45-degree field of view. 1920x1088px. Color fundus image.
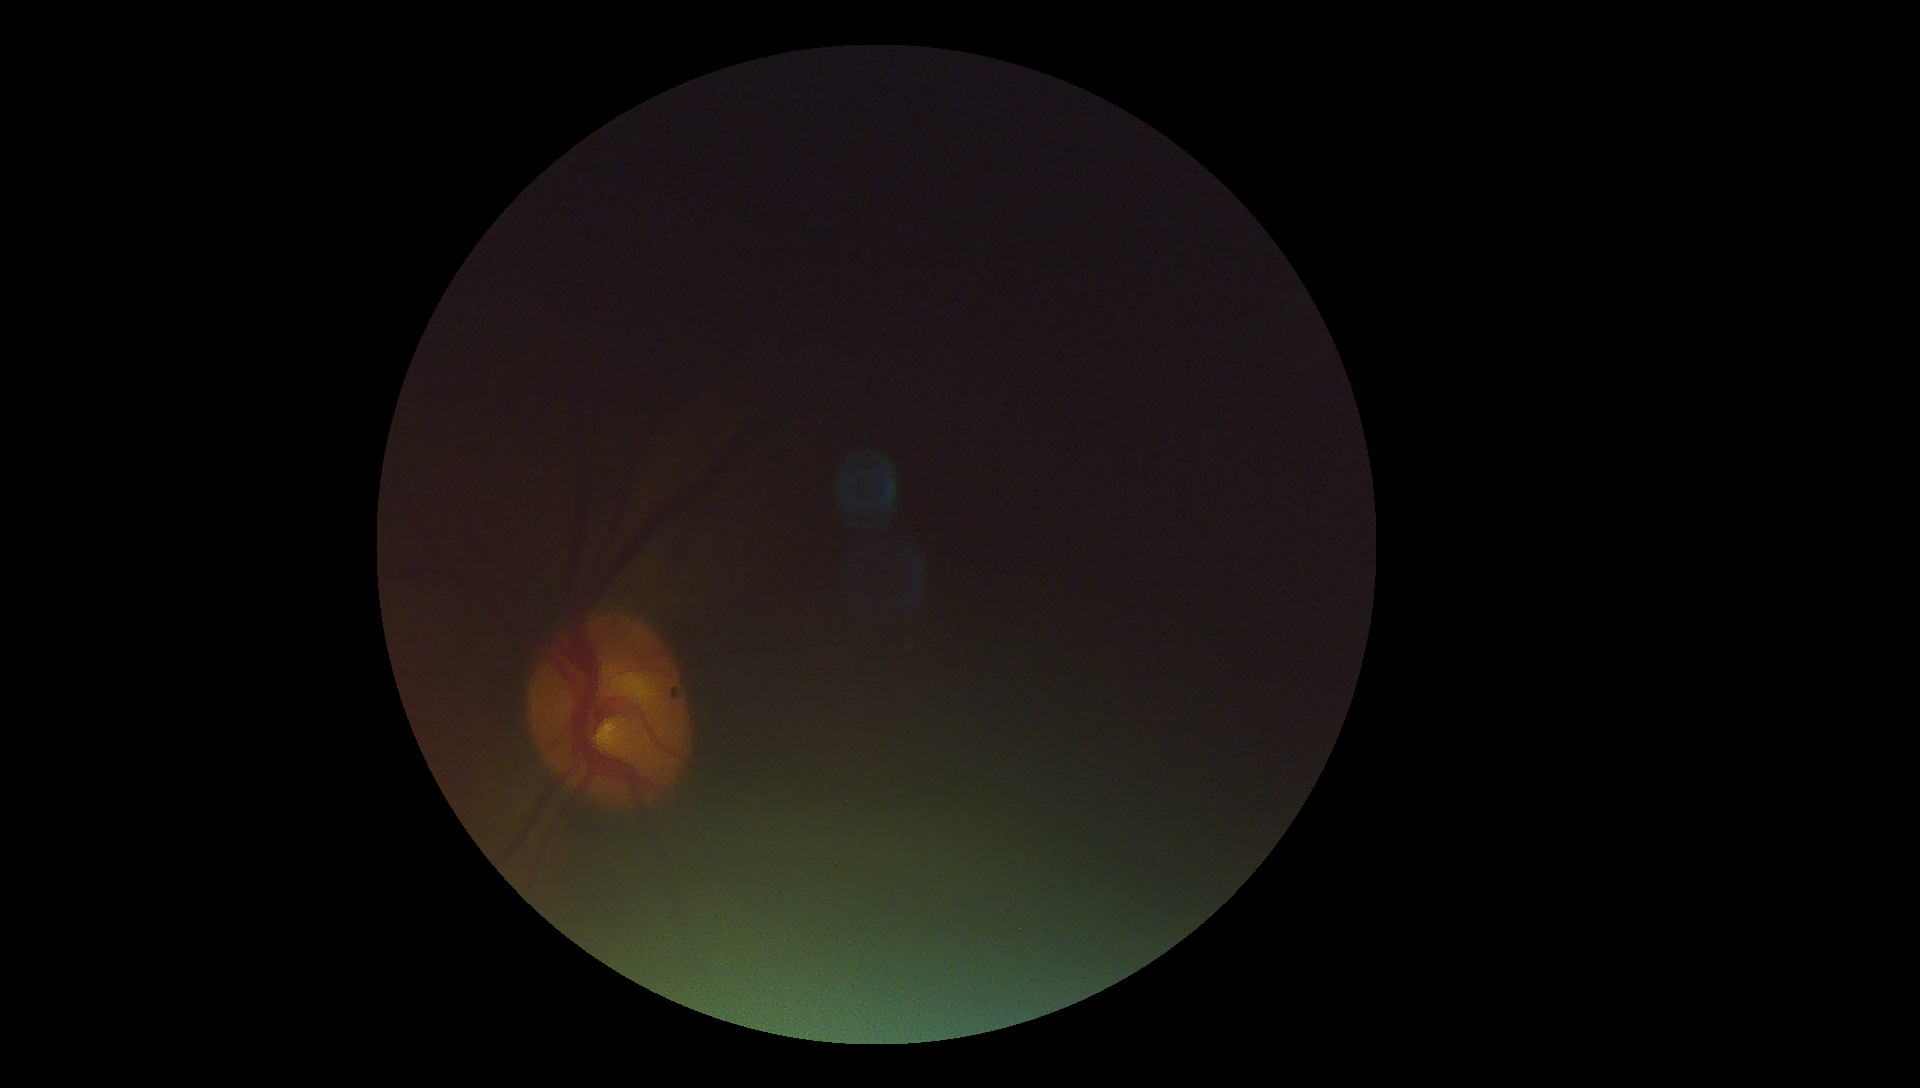

Annotations:
– DR severity: ungradable
– image quality: insufficient